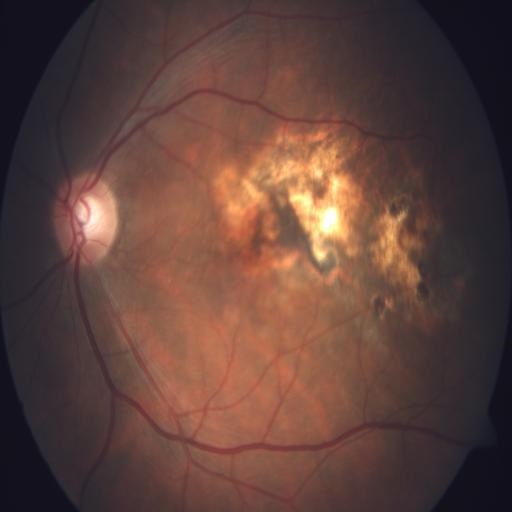
Fundus image with findings of CRS (chorioretinitis).